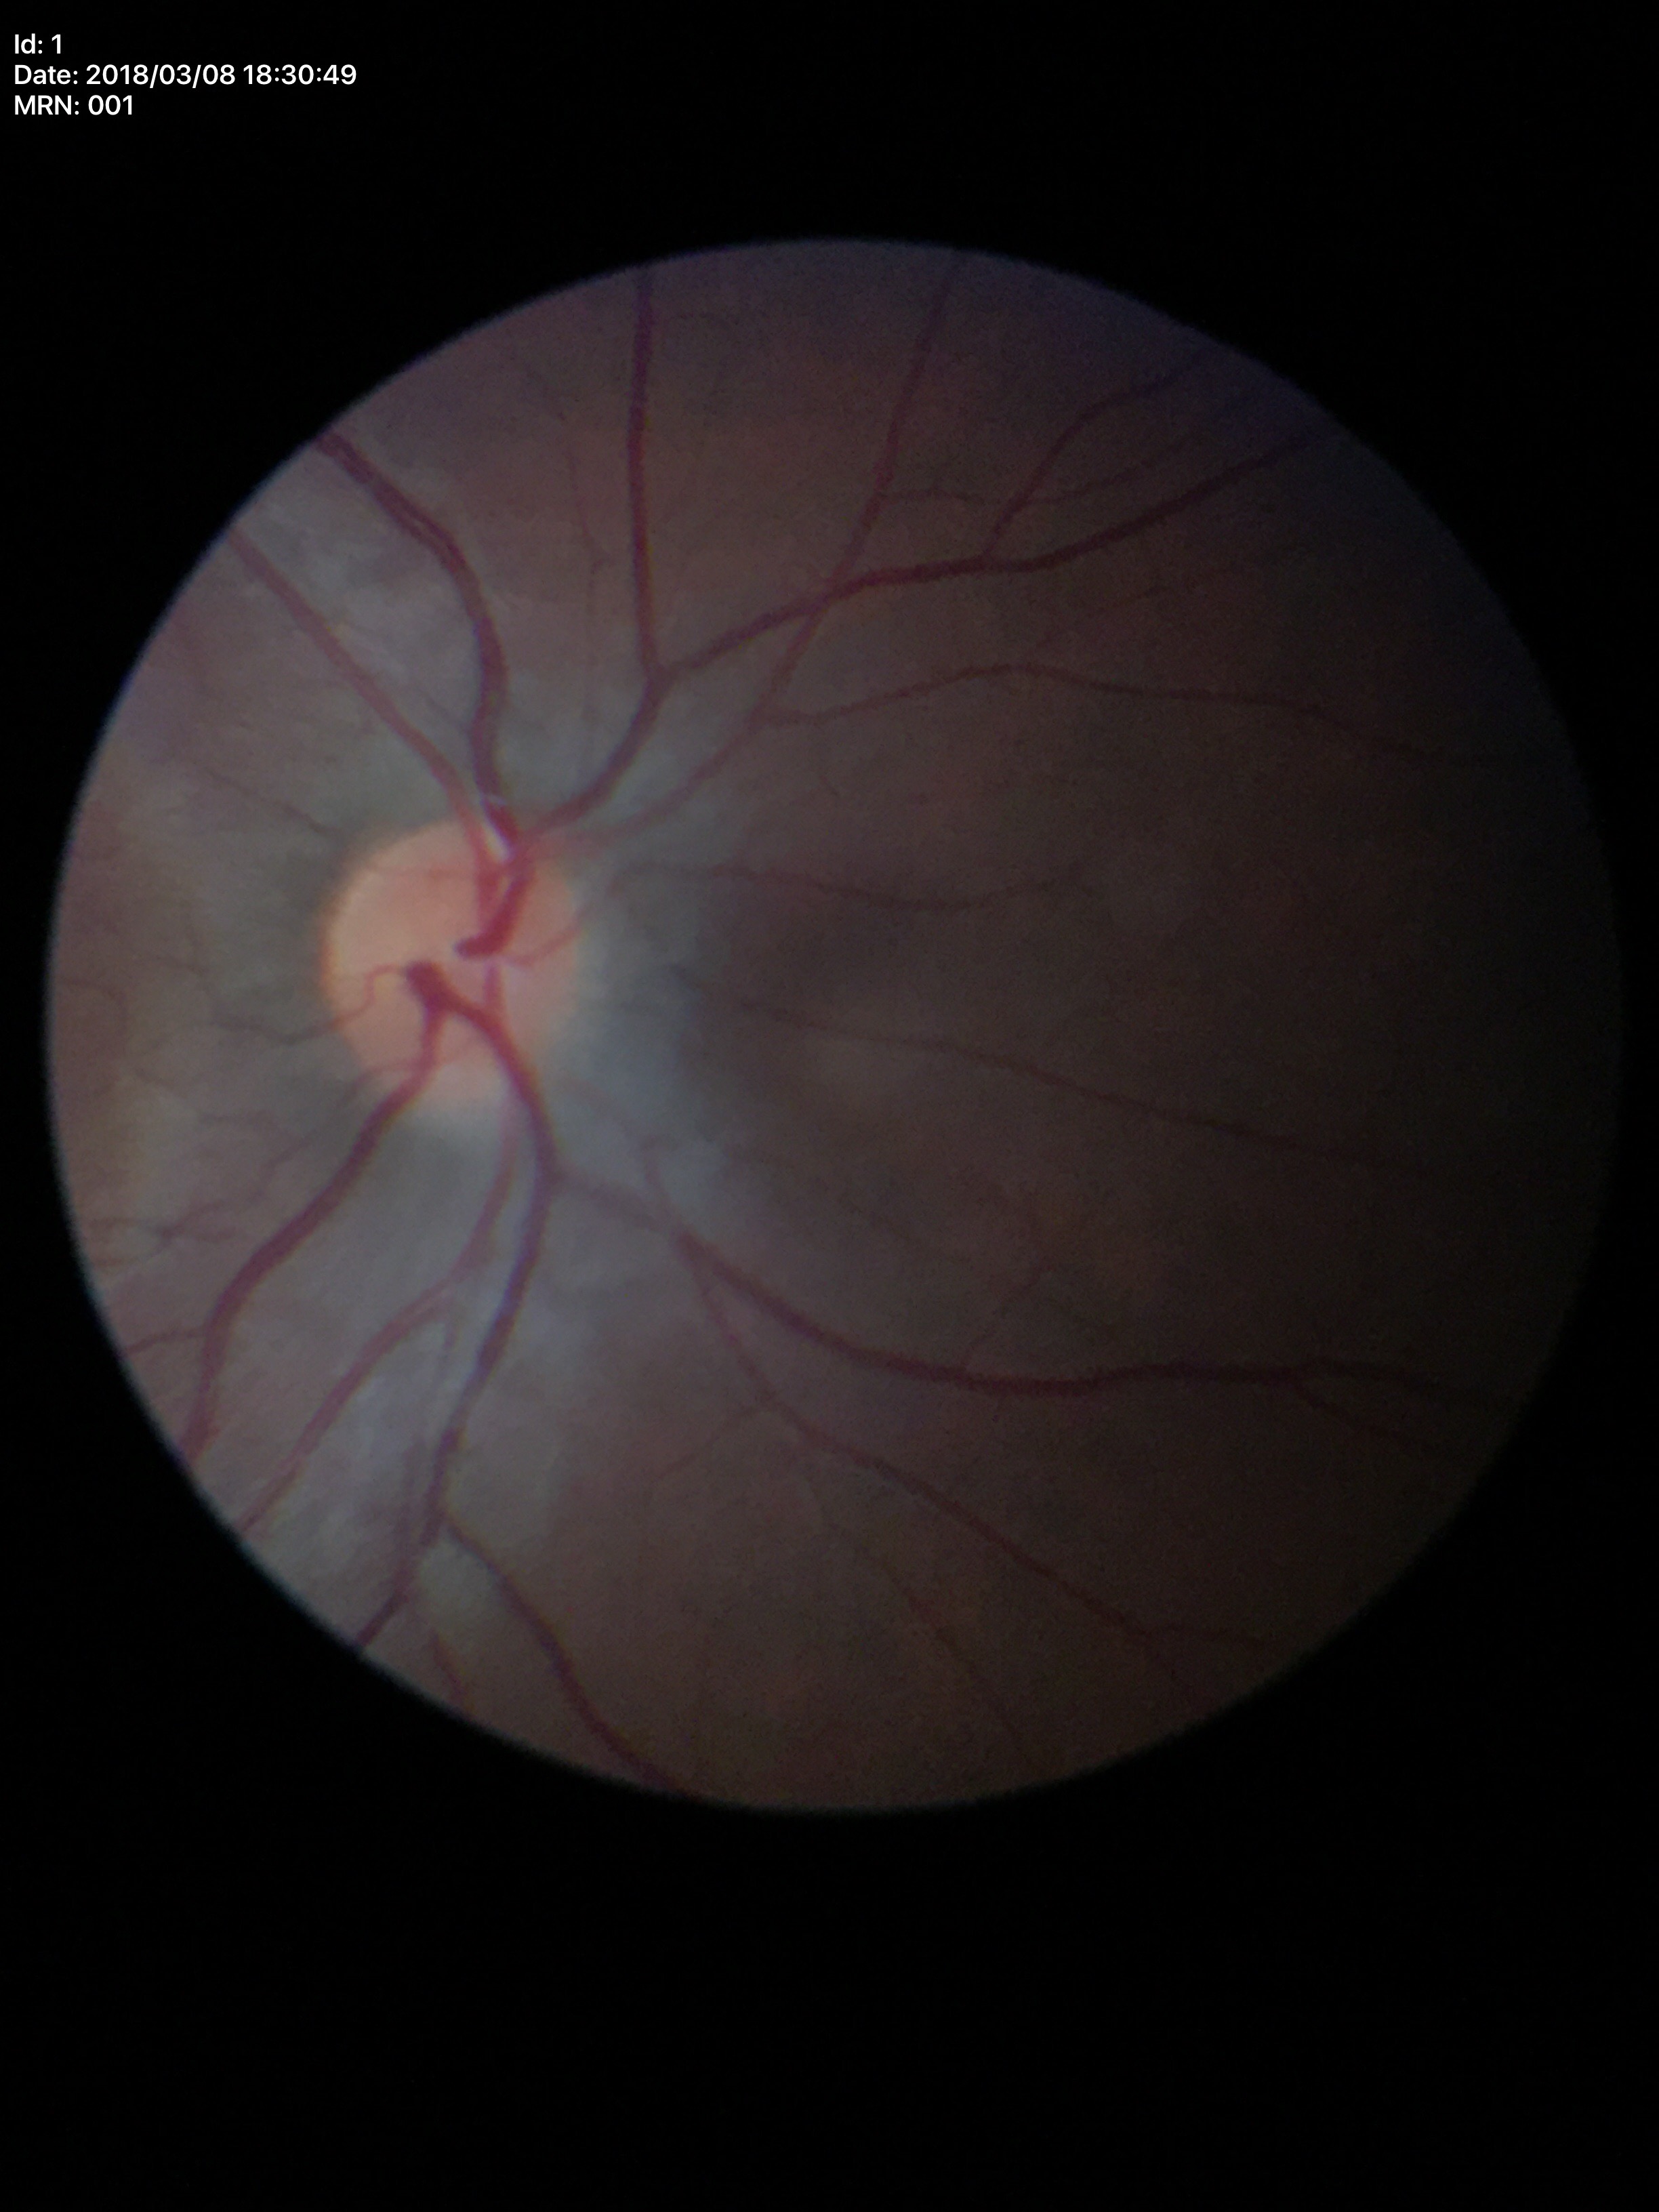

vertical cup-to-disc ratio: 0.45 | horizontal cup-to-disc ratio: 0.47 | Glaucoma screening impression: negative.